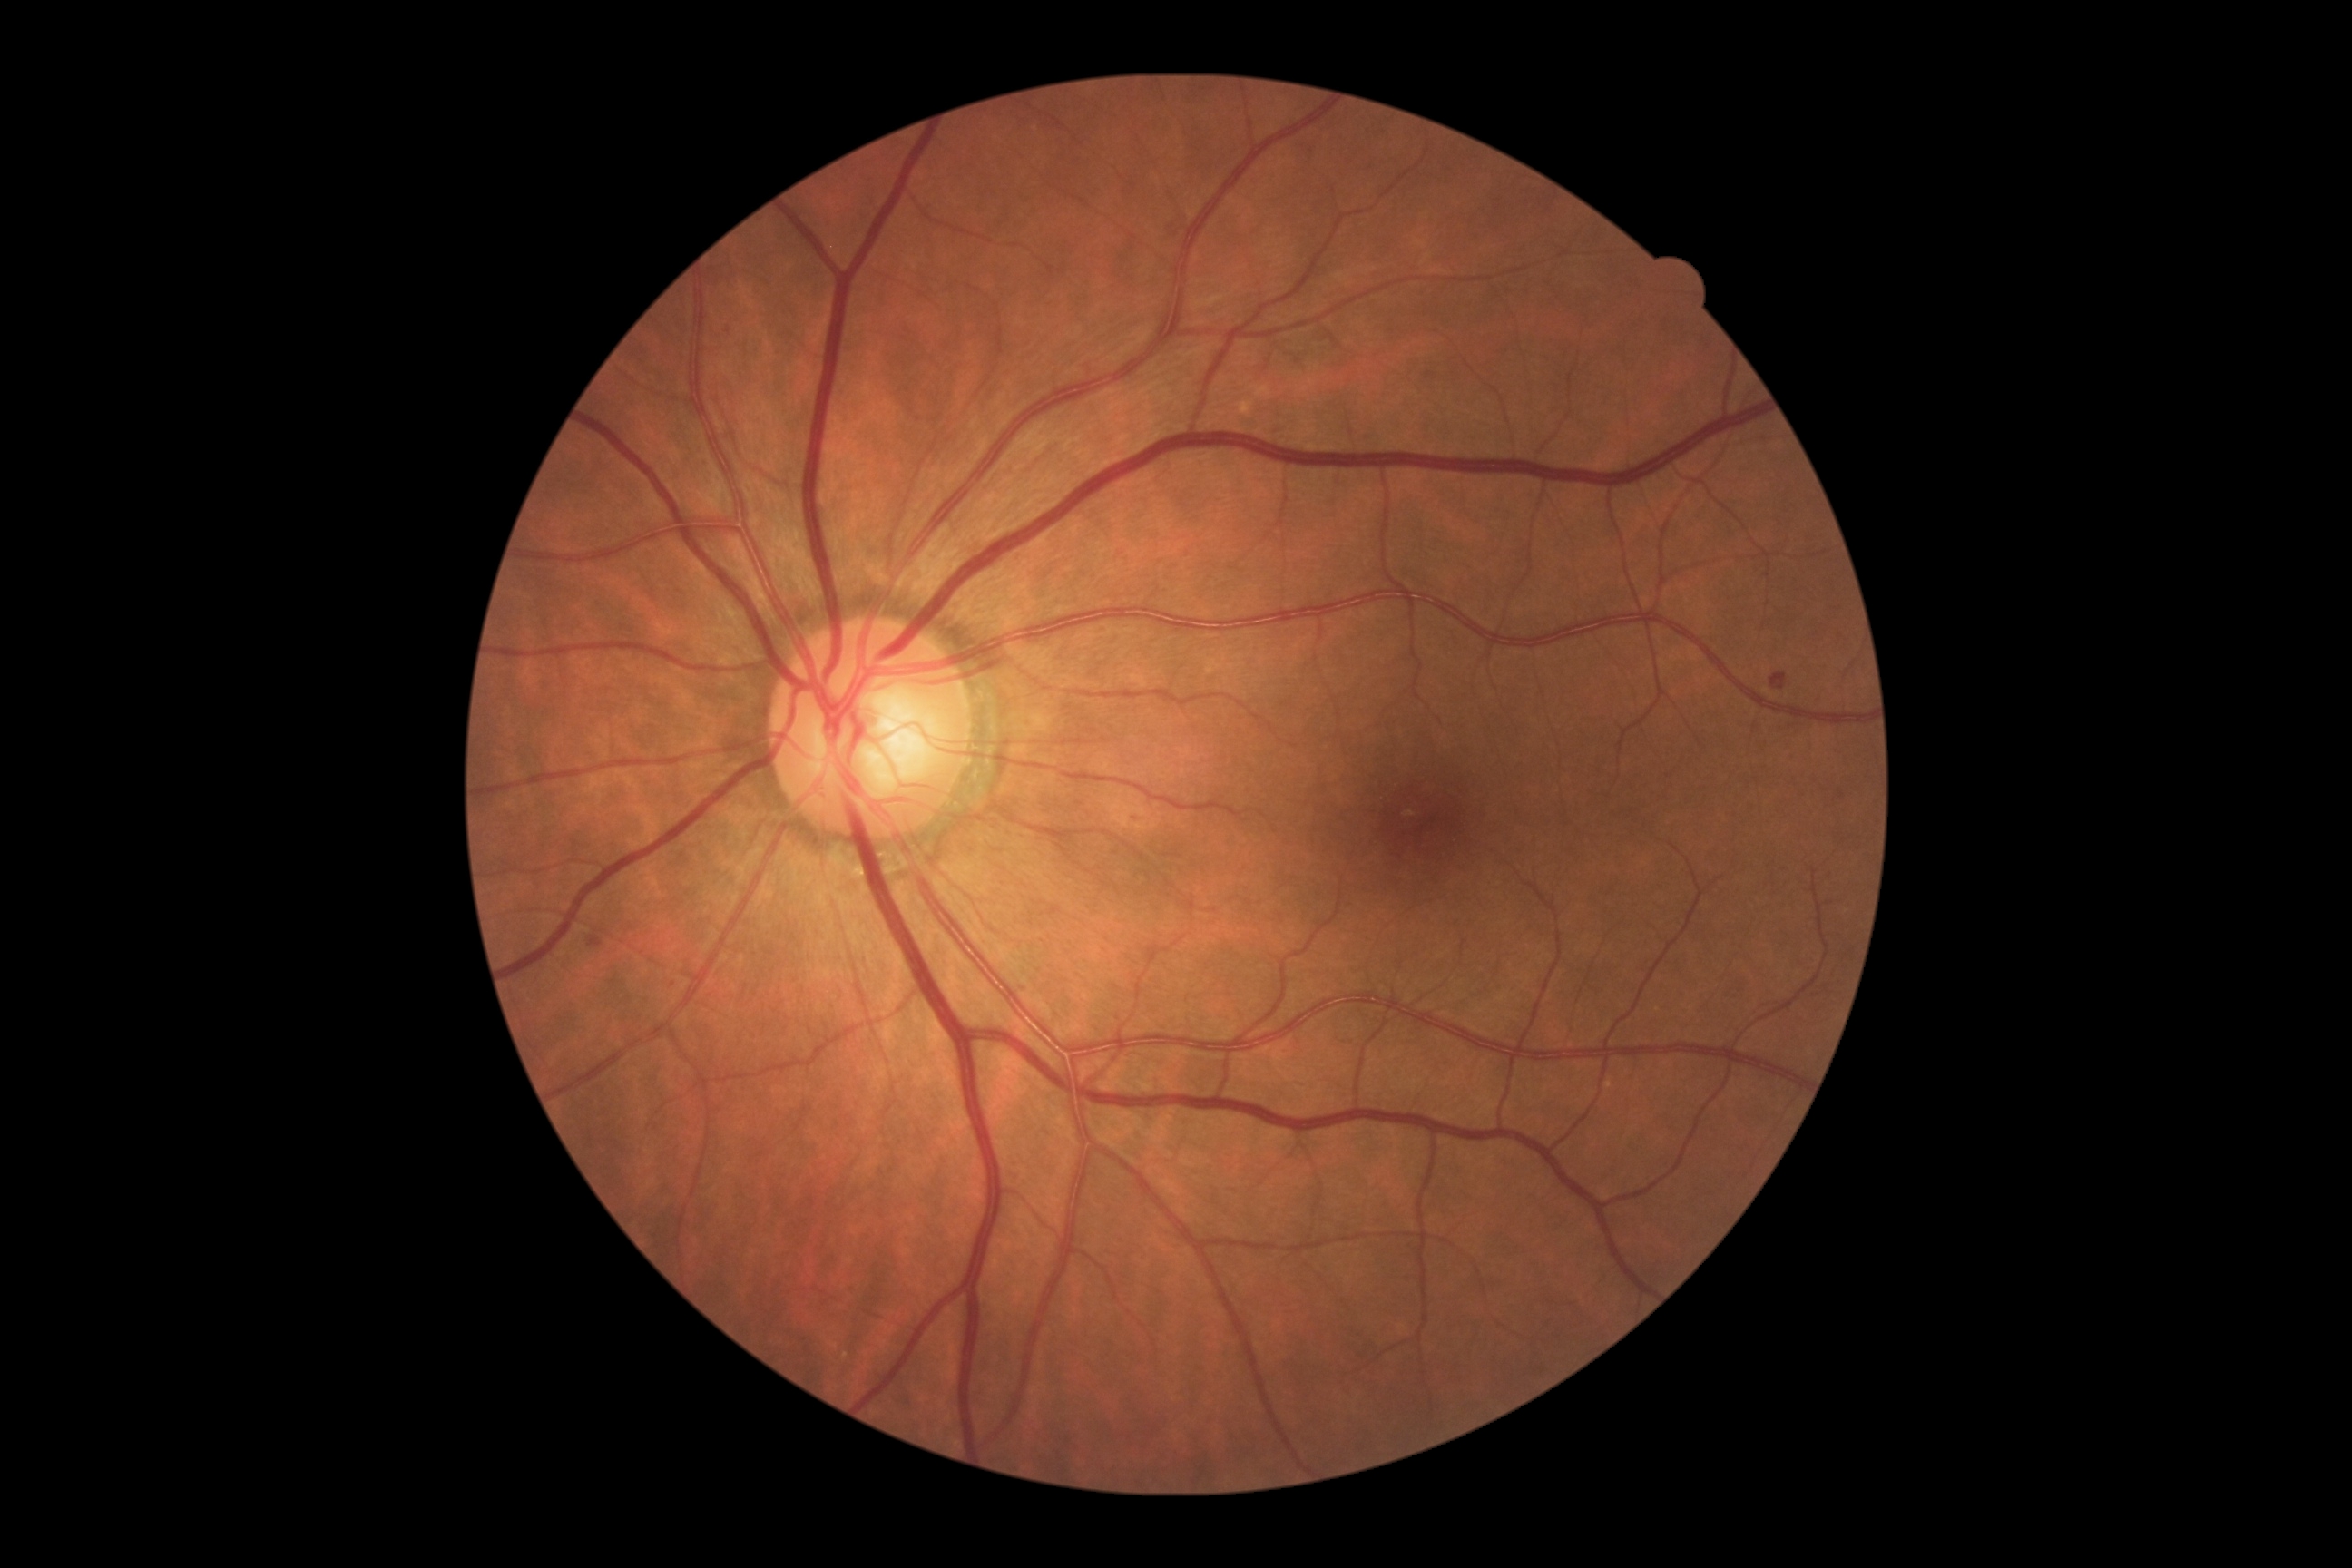 Diabetic retinopathy (DR) is mild non-proliferative diabetic retinopathy (grade 1) — presence of microaneurysms only.